Camera: Natus RetCam Envision (130° FOV). Infant wide-field fundus photograph — 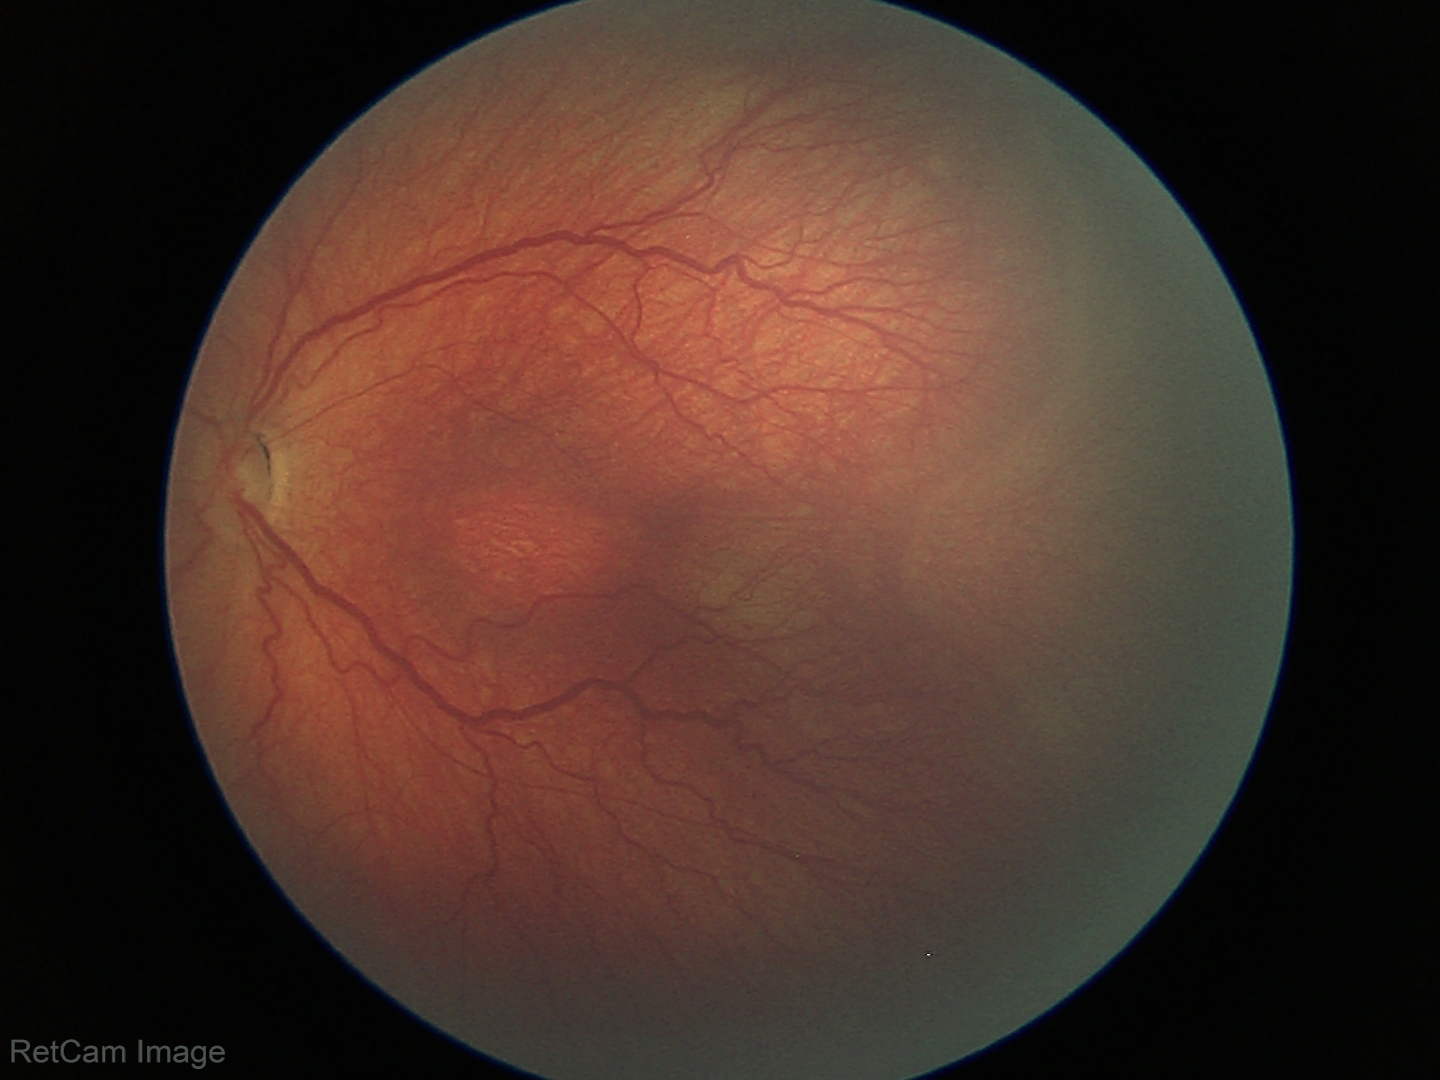
ROP grade: stage 3 | plus form: absent — posterior pole vessels without abnormal dilation or tortuosity.